Wide-field fundus image from infant ROP screening: 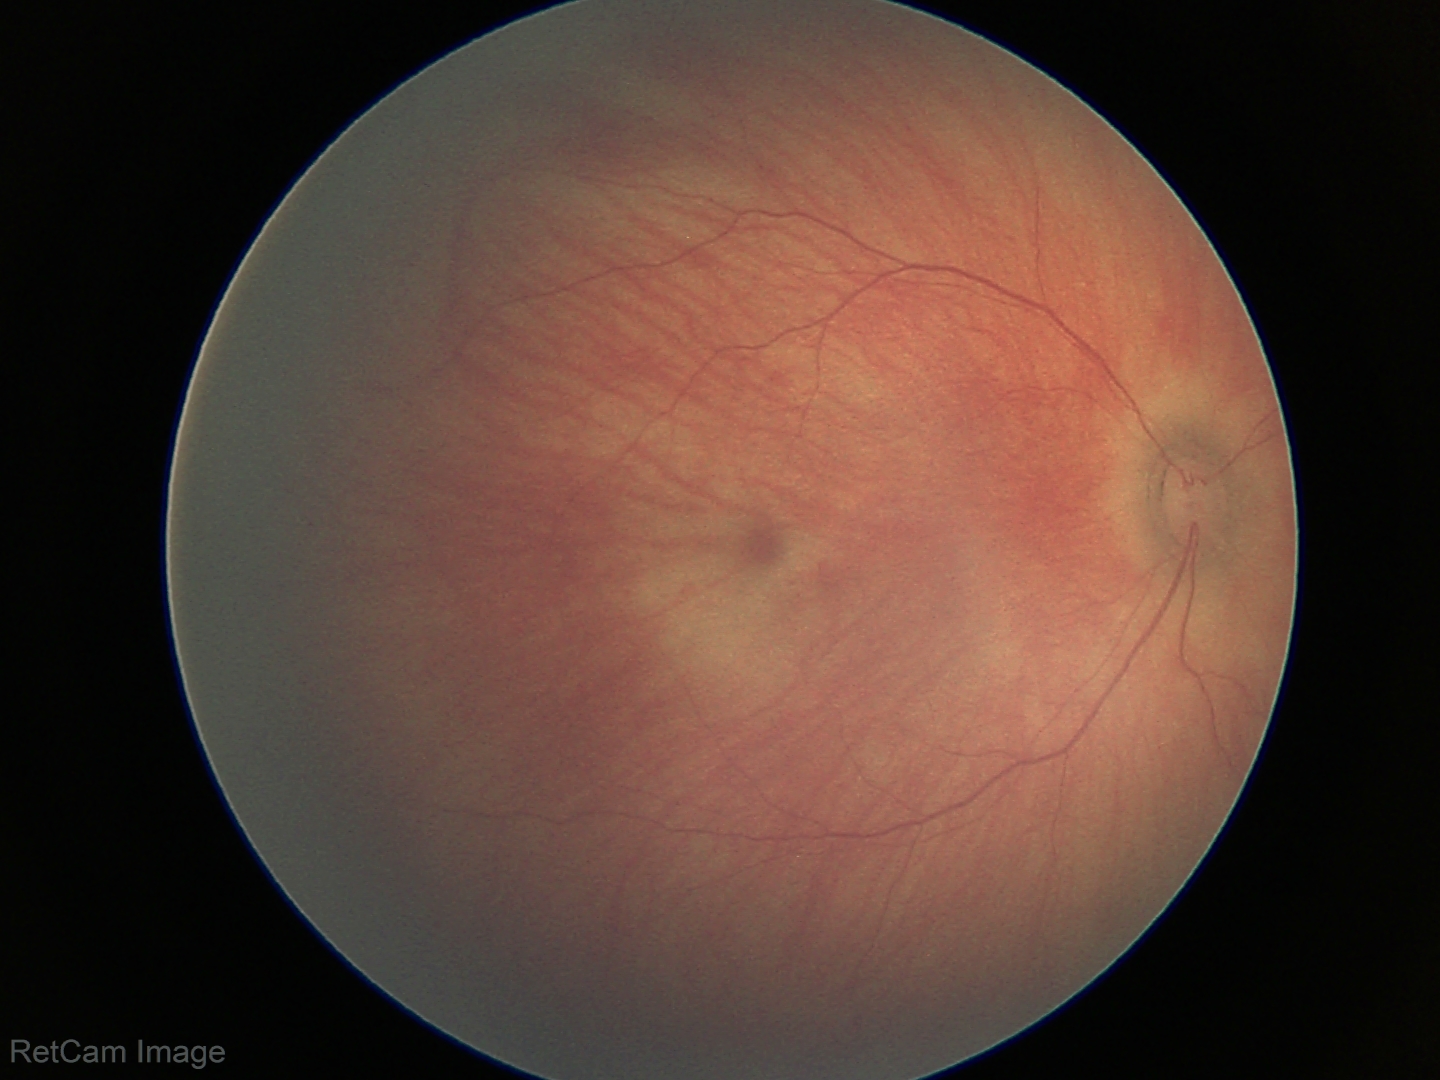 Screening examination diagnosed as physiological.